Retinal fundus photograph — 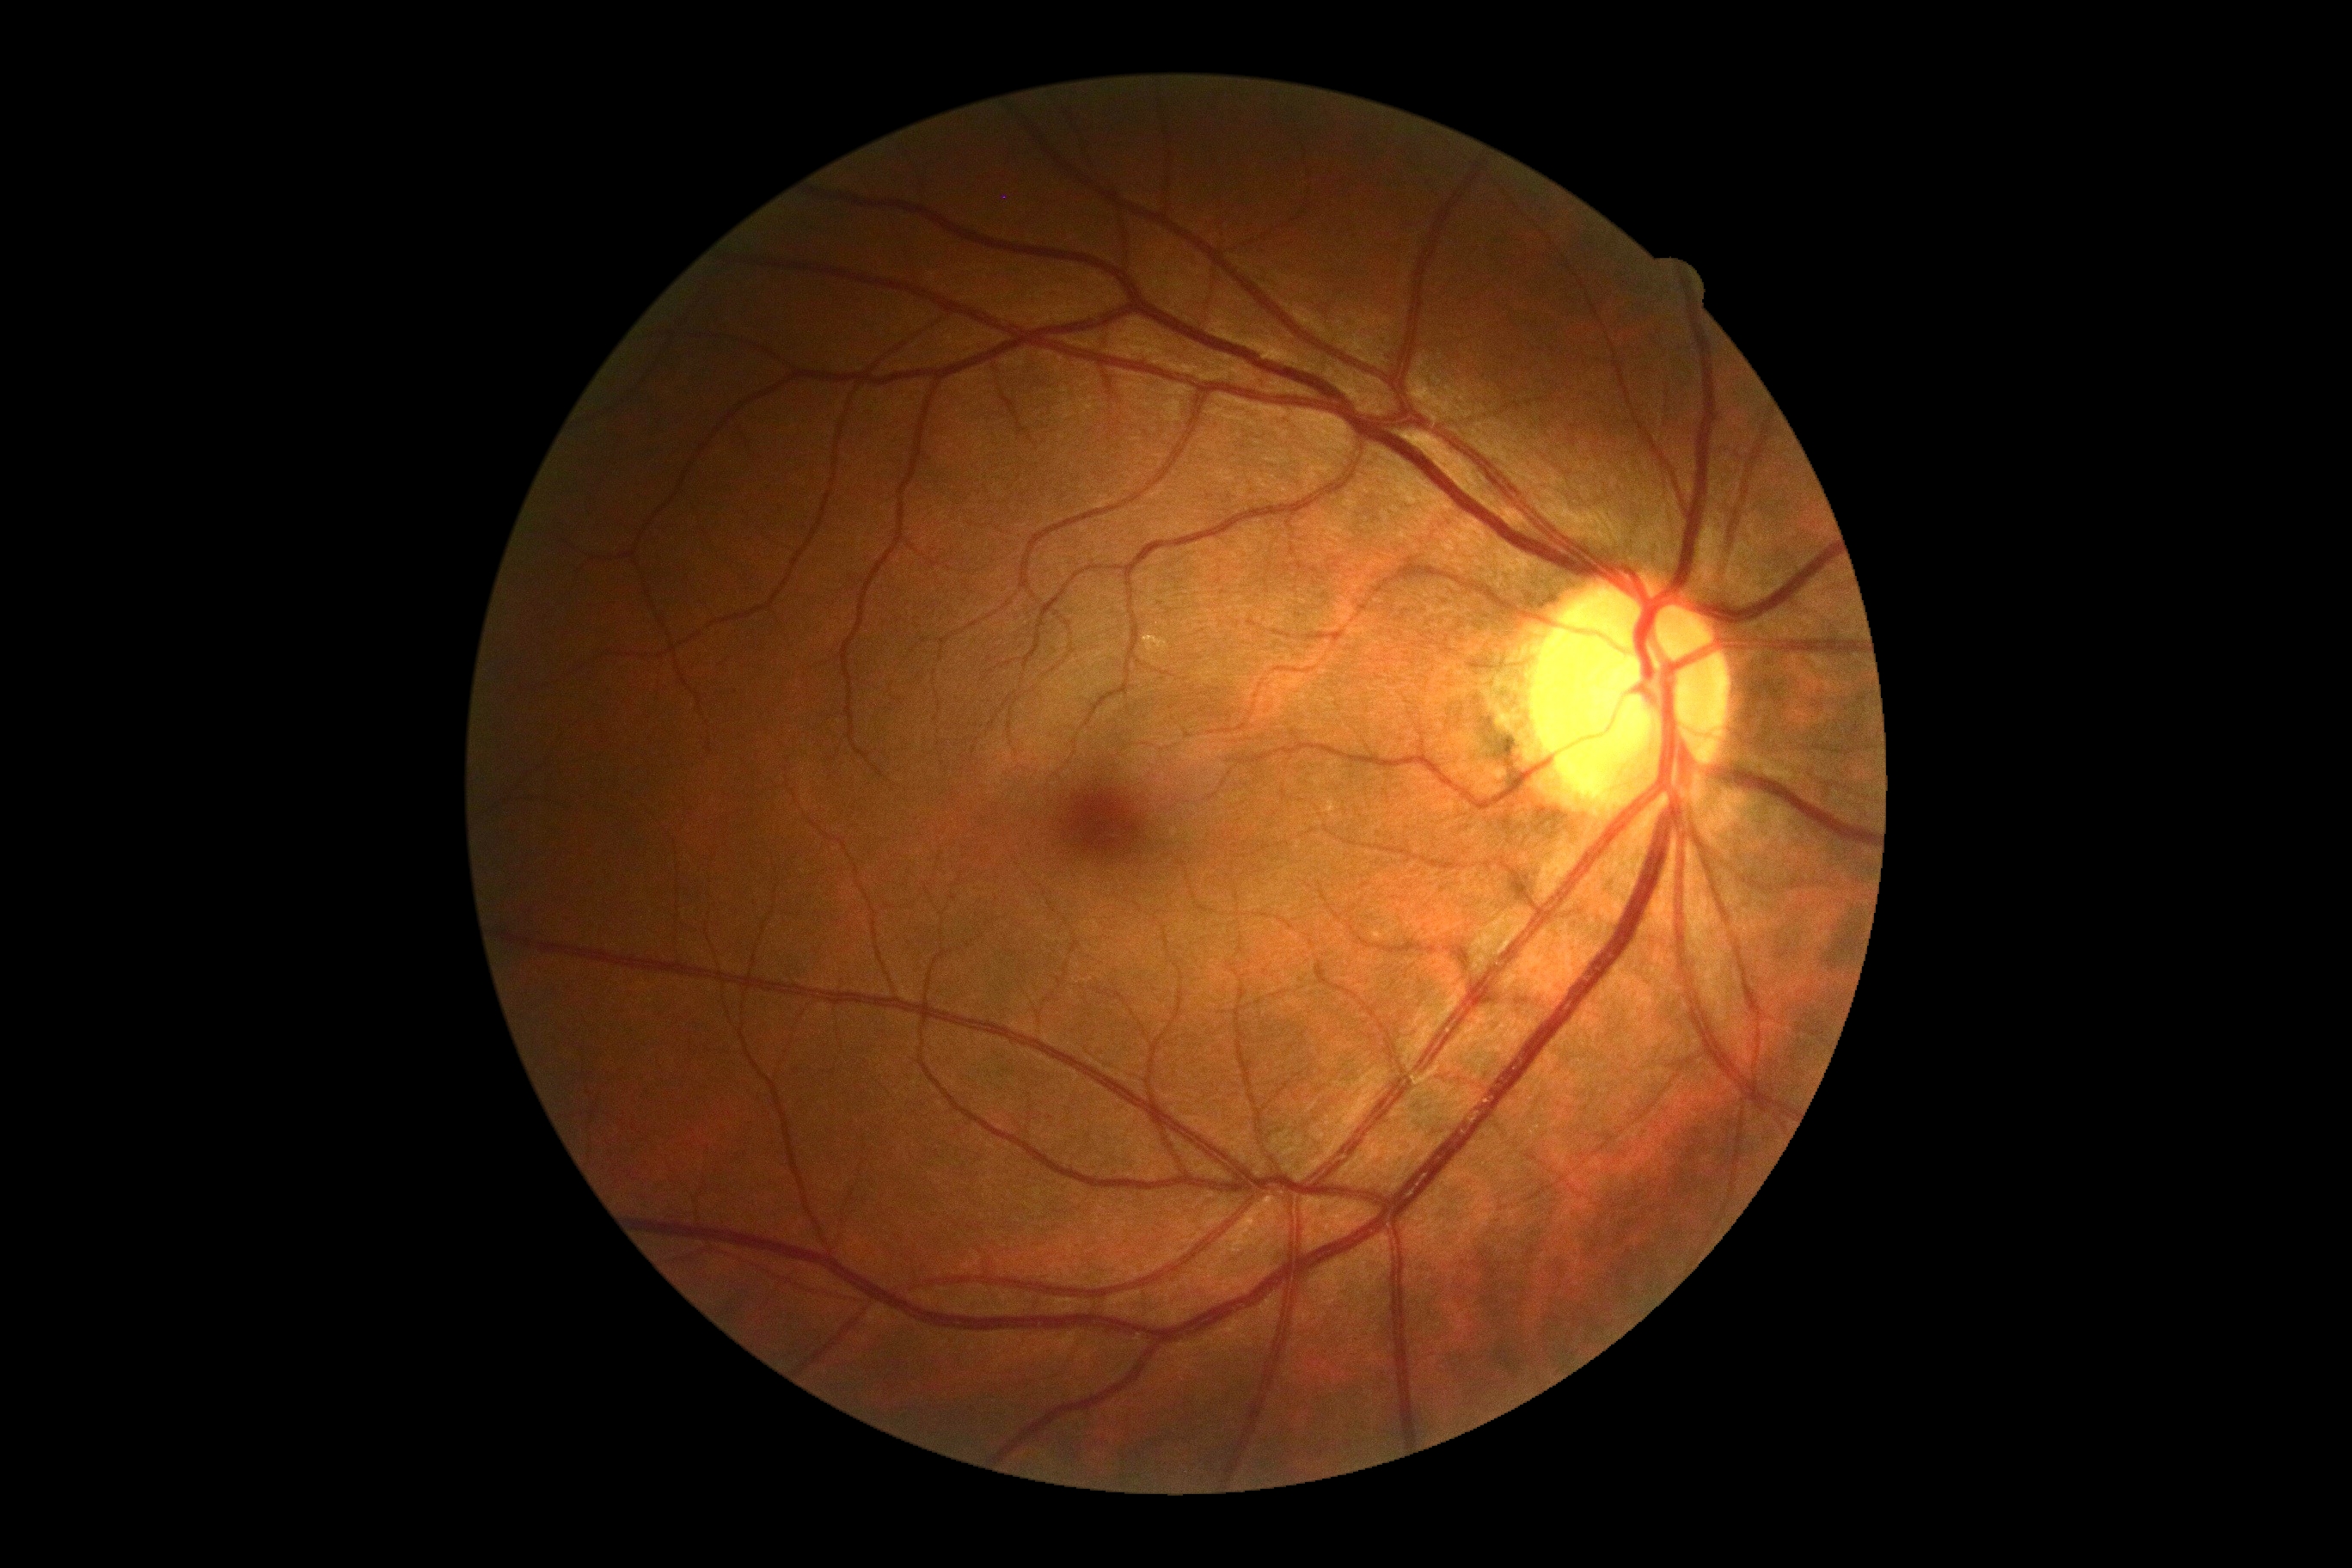 {
  "dr_grade": "0"
}